1240x1240px · Phoenix ICON, 100° FOV · Phoenix ICON wide-field infant fundus image
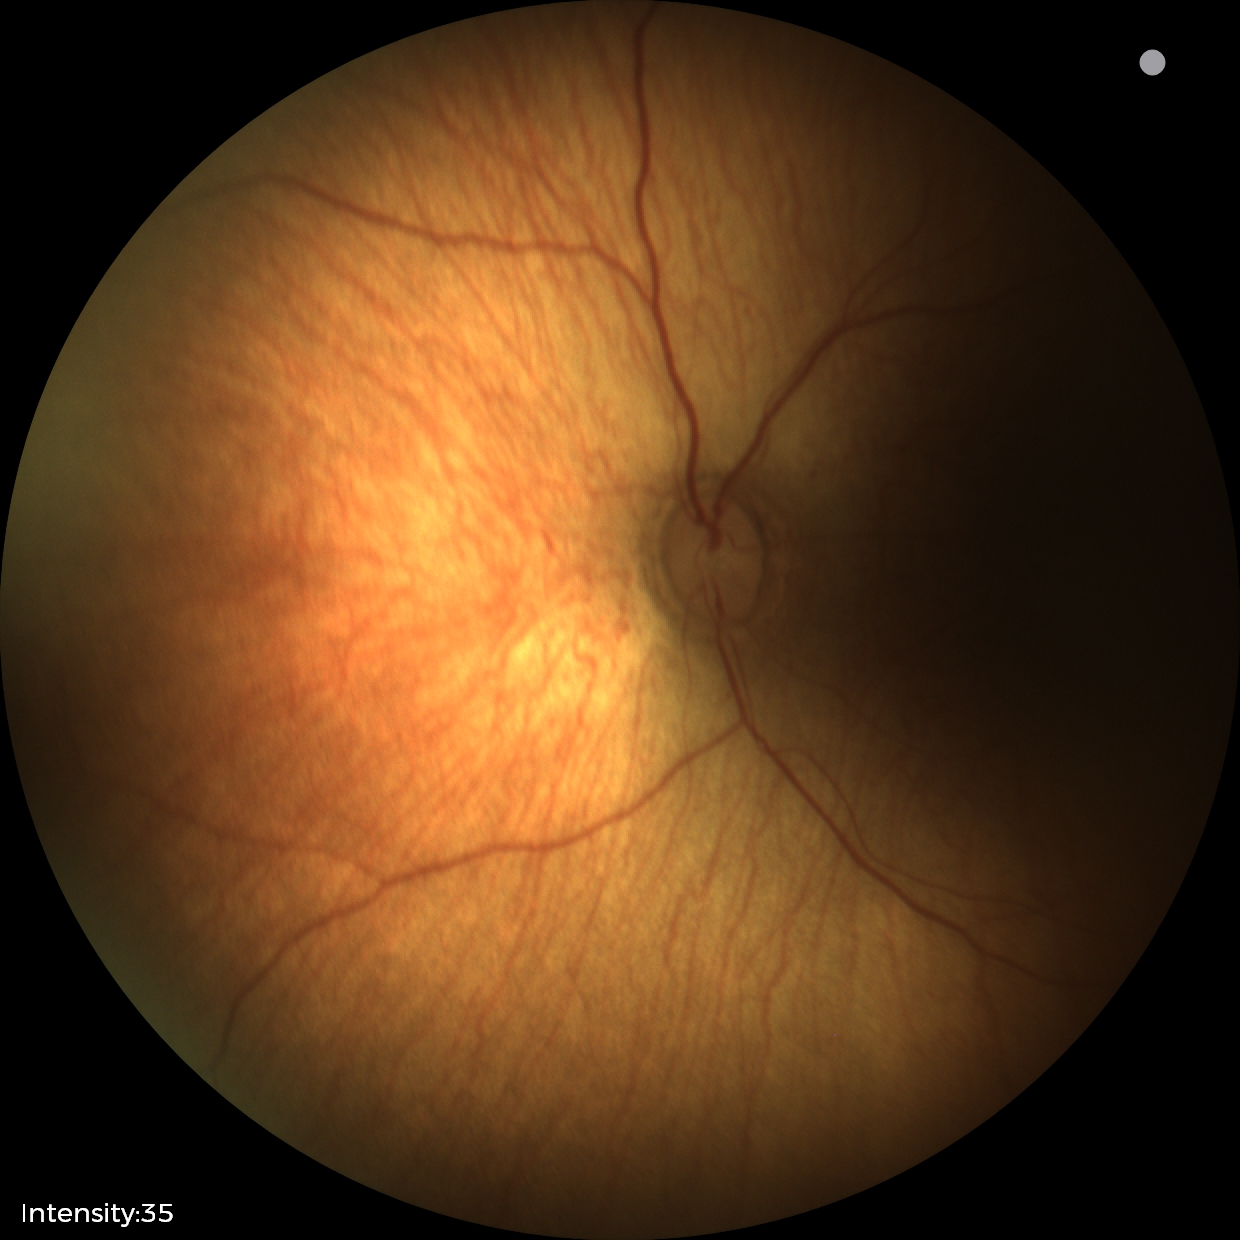 Screening series with status post retinopathy of prematurity (ROP). No plus disease.